Color fundus photograph: 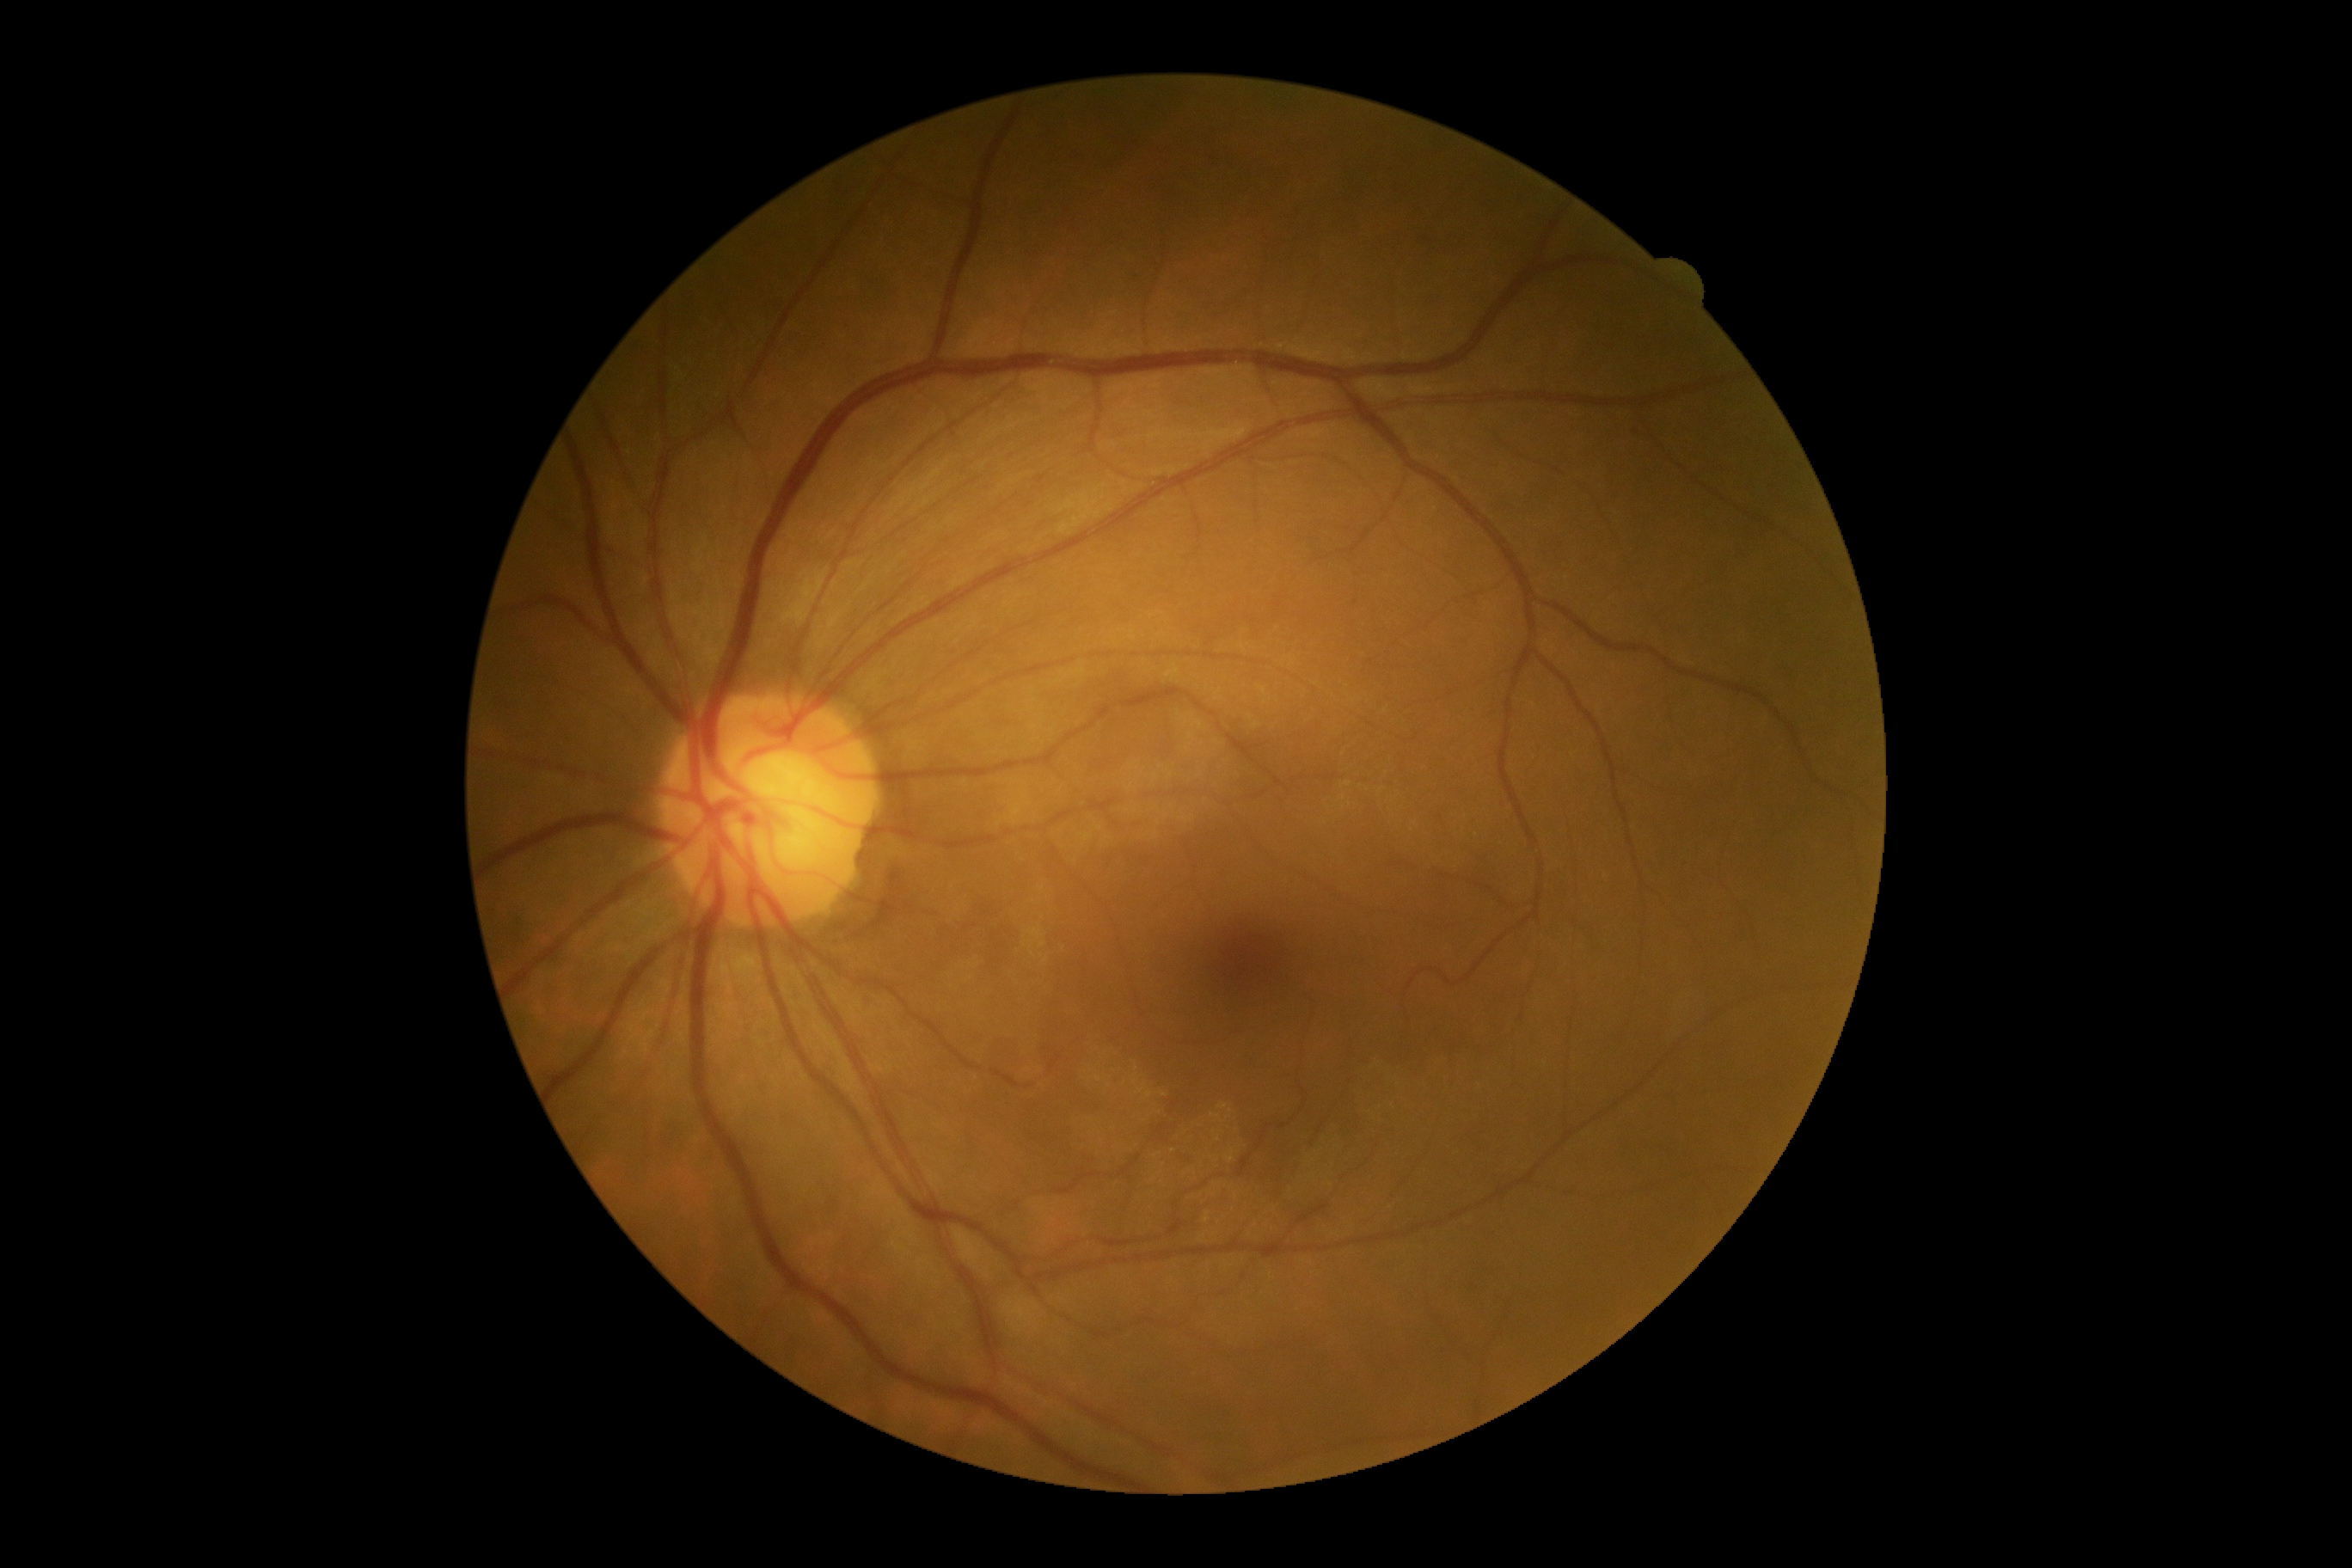

DR impression = no signs of DR
diabetic retinopathy (DR) = 0